45-degree field of view:
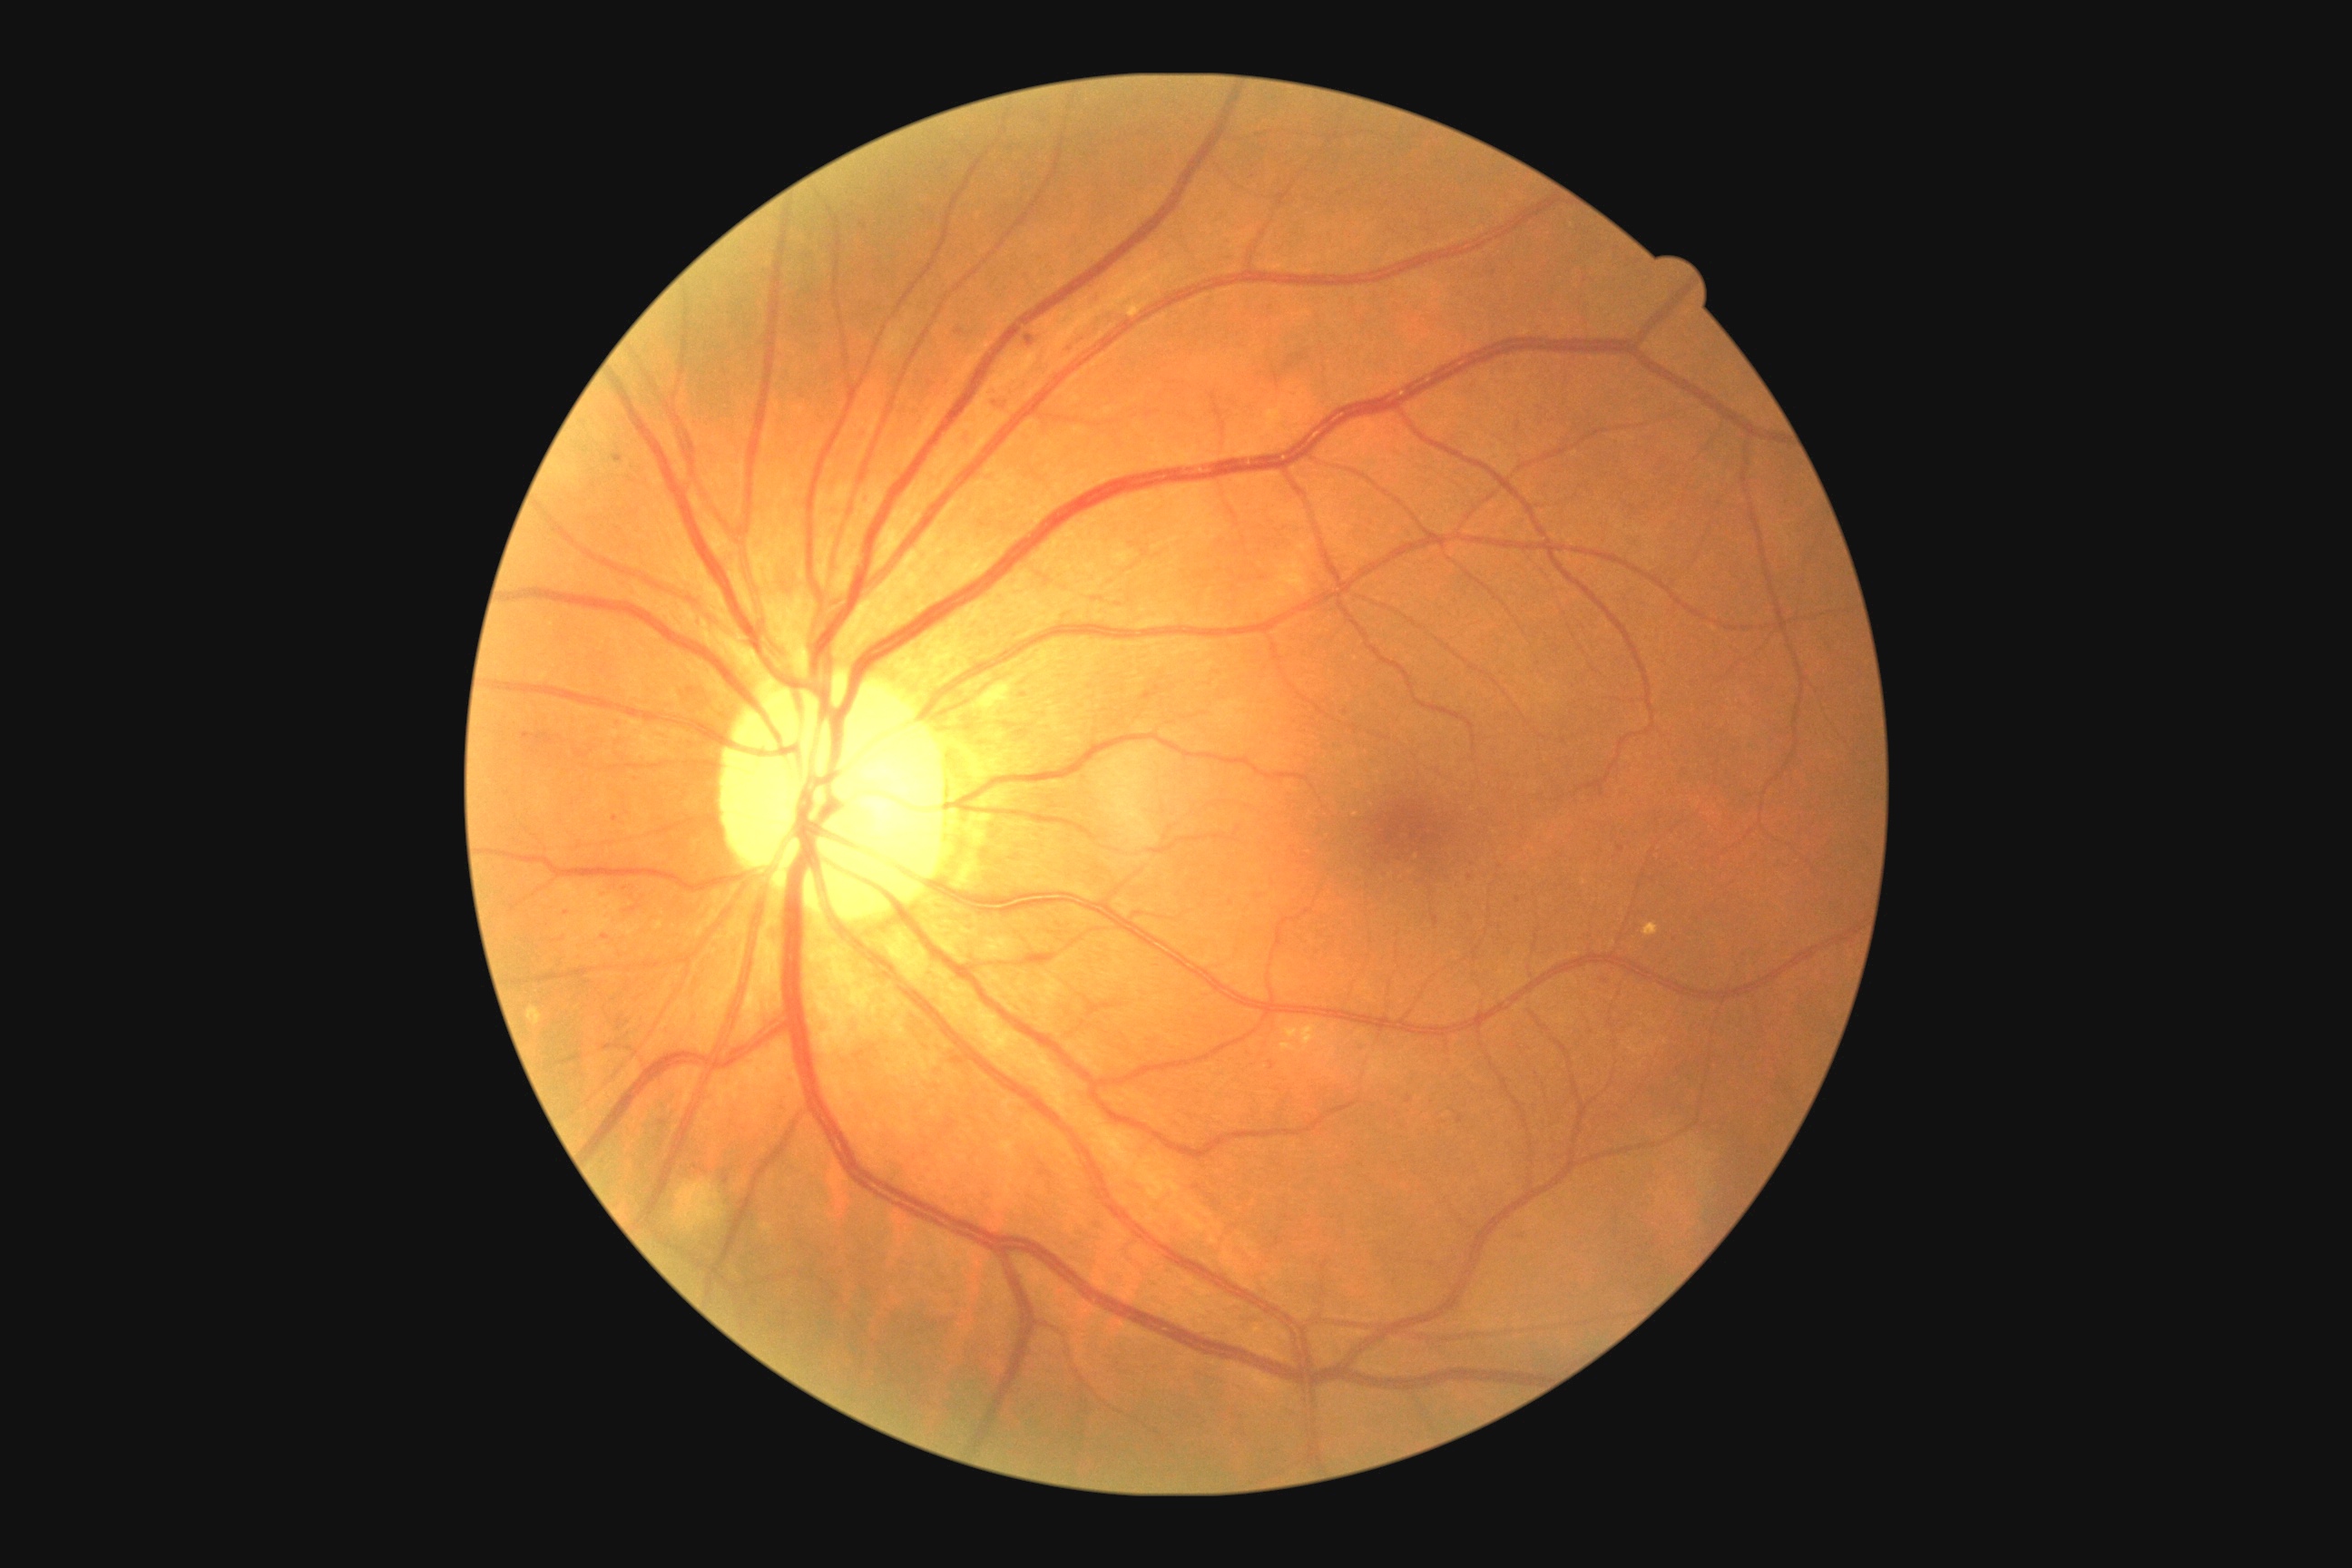 DR stage is 2. MAs include lesions at (865,498,868,507) | (1026,335,1034,348) | (968,431,975,442) | (522,732,531,740) | (1093,295,1104,306) | (696,620,701,629). Small MAs near (634,910) | (959,332) | (727,1180) | (1470,878) | (1023,695).